640x480px · wide-field contact fundus photograph of an infant — 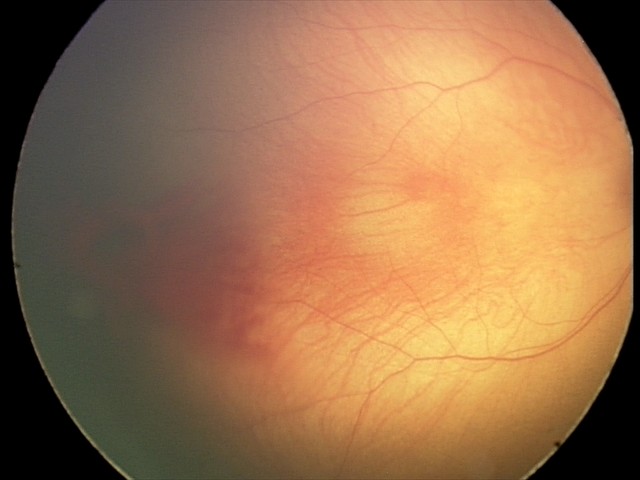
Series diagnosed as retinal hemorrhages.